Fundus photo
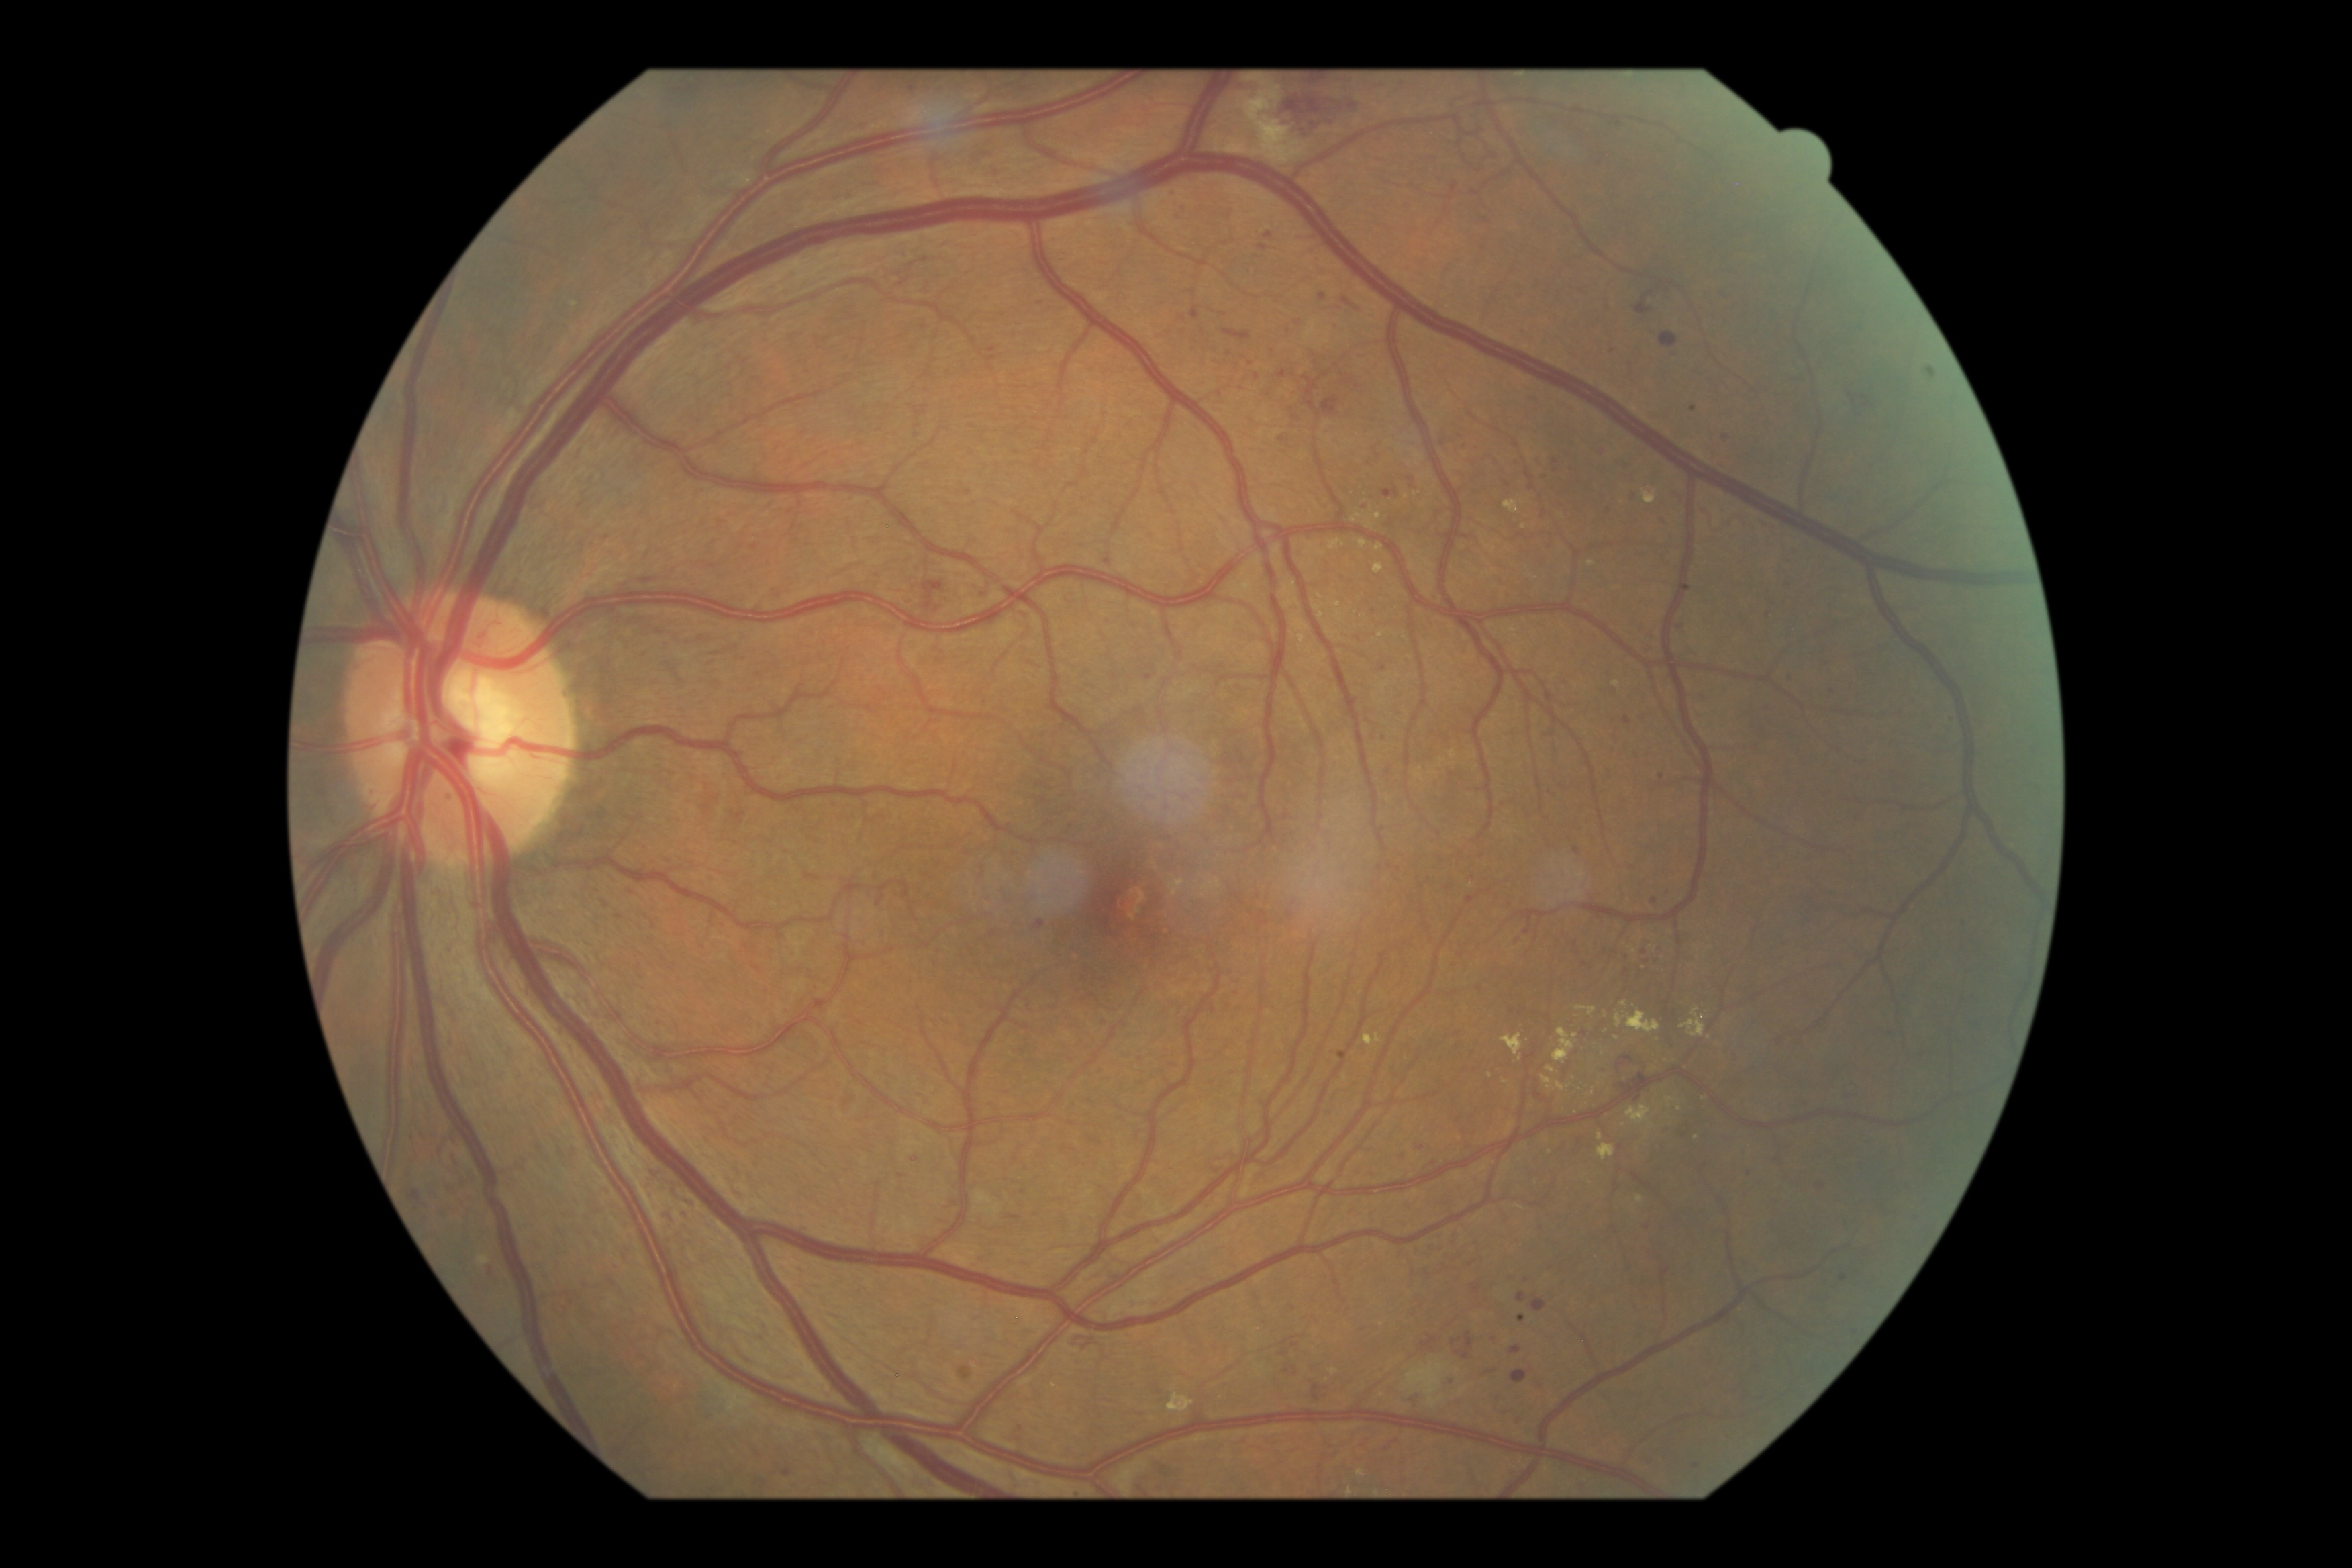

Diabetic retinopathy (DR): severe NPDR (grade 3)
Selected lesions:
• hard exudates (EXs) (more not shown): {"left": 1504, "top": 500, "right": 1523, "bottom": 515}; {"left": 1367, "top": 522, "right": 1374, "bottom": 530}; {"left": 1553, "top": 1029, "right": 1578, "bottom": 1065}; {"left": 1587, "top": 562, "right": 1596, "bottom": 566}; {"left": 1577, "top": 1006, "right": 1596, "bottom": 1016}; {"left": 1547, "top": 1067, "right": 1557, "bottom": 1073}; {"left": 1506, "top": 1122, "right": 1515, "bottom": 1136}; {"left": 1374, "top": 565, "right": 1383, "bottom": 575}; {"left": 1667, "top": 1097, "right": 1676, "bottom": 1106}; {"left": 1502, "top": 1034, "right": 1523, "bottom": 1061}
• Small EXs near point(1594, 1094); point(1606, 1015); point(1616, 684); point(1680, 1109); point(1508, 1167)
• hemorrhages (HEs) (more not shown): {"left": 489, "top": 1265, "right": 499, "bottom": 1289}; {"left": 663, "top": 1214, "right": 676, "bottom": 1221}; {"left": 705, "top": 805, "right": 709, "bottom": 813}; {"left": 1457, "top": 1351, "right": 1469, "bottom": 1361}; {"left": 924, "top": 578, "right": 944, "bottom": 589}; {"left": 1618, "top": 1072, "right": 1645, "bottom": 1091}; {"left": 1312, "top": 1386, "right": 1320, "bottom": 1402}; {"left": 1843, "top": 393, "right": 1868, "bottom": 402}; {"left": 1660, "top": 332, "right": 1677, "bottom": 350}; {"left": 1531, "top": 1297, "right": 1547, "bottom": 1314}; {"left": 1465, "top": 1334, "right": 1475, "bottom": 1349}; {"left": 1322, "top": 397, "right": 1339, "bottom": 417}
• microaneurysms (MAs) (more not shown): {"left": 1518, "top": 1416, "right": 1523, "bottom": 1425}; {"left": 1518, "top": 1295, "right": 1527, "bottom": 1303}; {"left": 1191, "top": 308, "right": 1199, "bottom": 322}; {"left": 1624, "top": 718, "right": 1632, "bottom": 724}; {"left": 1358, "top": 351, "right": 1367, "bottom": 358}; {"left": 1830, "top": 688, "right": 1836, "bottom": 699}; {"left": 1369, "top": 461, "right": 1374, "bottom": 469}; {"left": 1647, "top": 1224, "right": 1655, "bottom": 1228}
• Small MAs near point(755, 548); point(1751, 1175); point(1183, 208); point(1519, 465); point(1532, 489); point(608, 540); point(1655, 902); point(1680, 627); point(1496, 463); point(1184, 319); point(1576, 850)